Retinal fundus photograph · NIDEK AFC-230 · without pupil dilation · 848 by 848 pixels · FOV: 45 degrees:
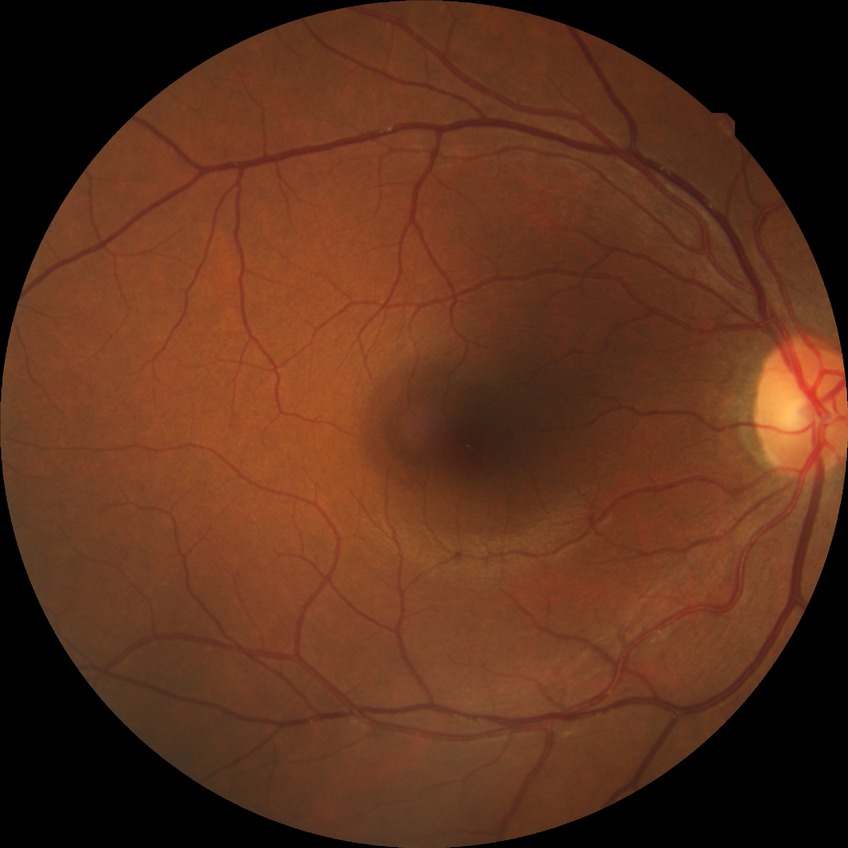
{"davis_grade": "no diabetic retinopathy (NDR)"}